Captured with the Clarity RetCam 3 (130° field of view) · pediatric wide-field fundus photograph
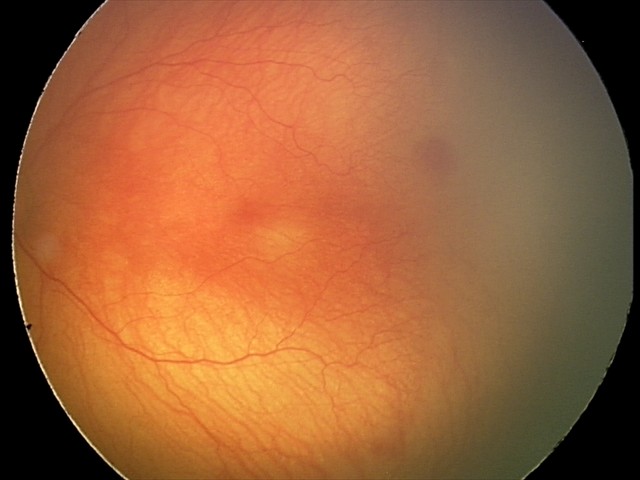
Impression: aggressive retinopathy of prematurity; plus disease.